100° field of view (Phoenix ICON); infant wide-field fundus photograph: 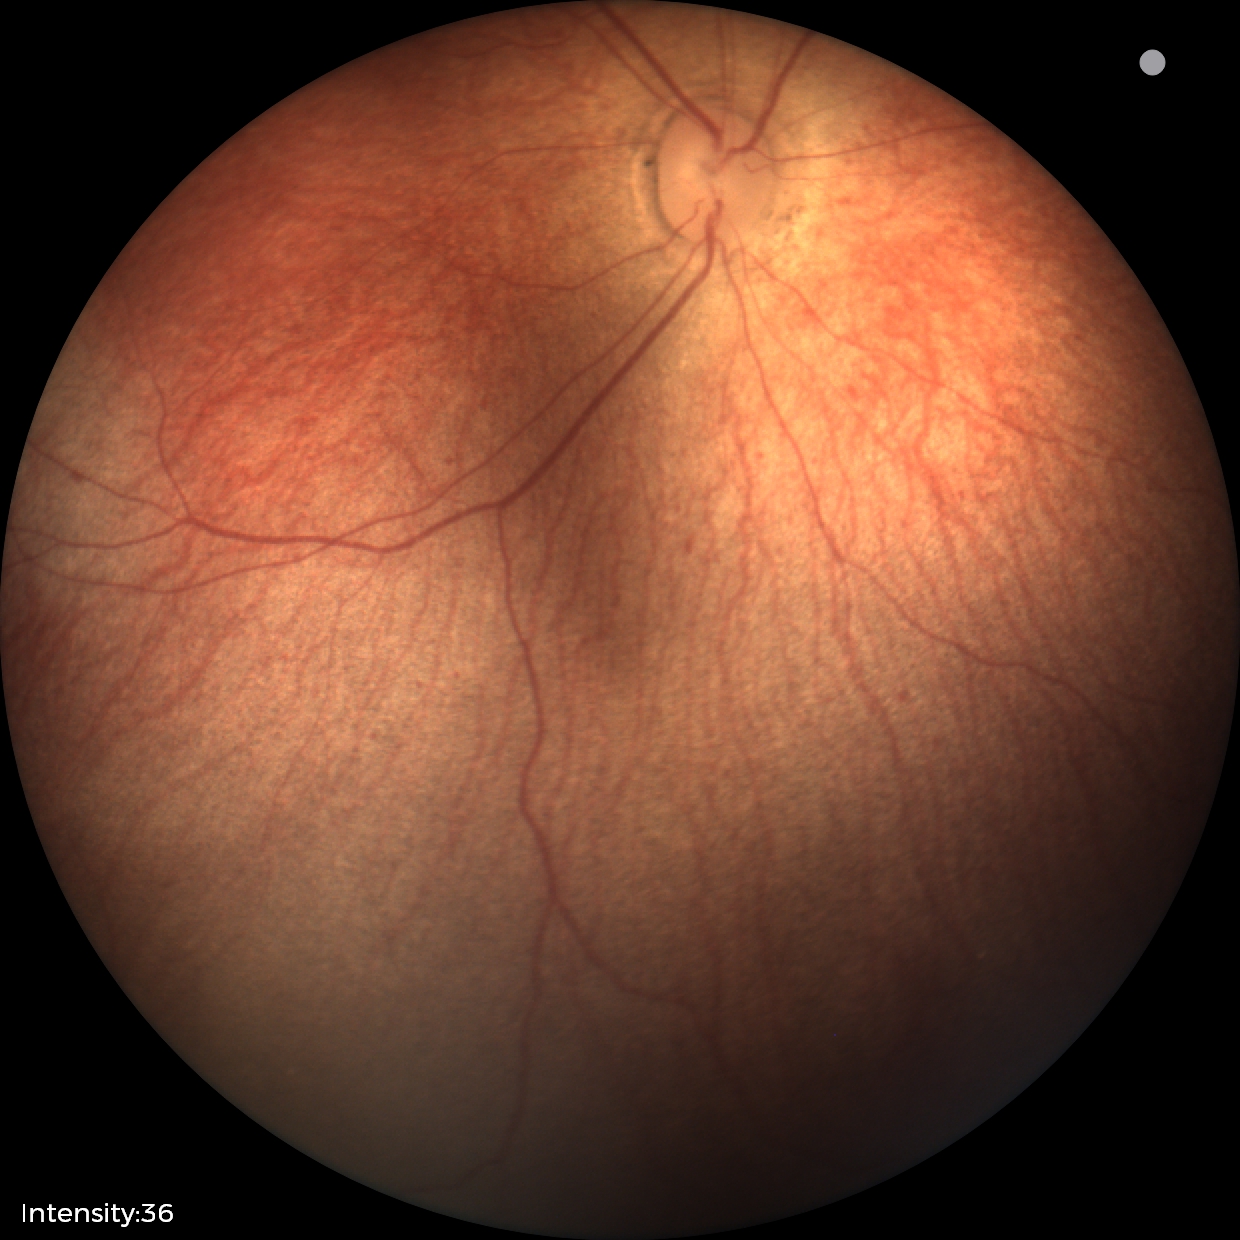
No retinal pathology identified on screening.